Retinal fundus photograph.
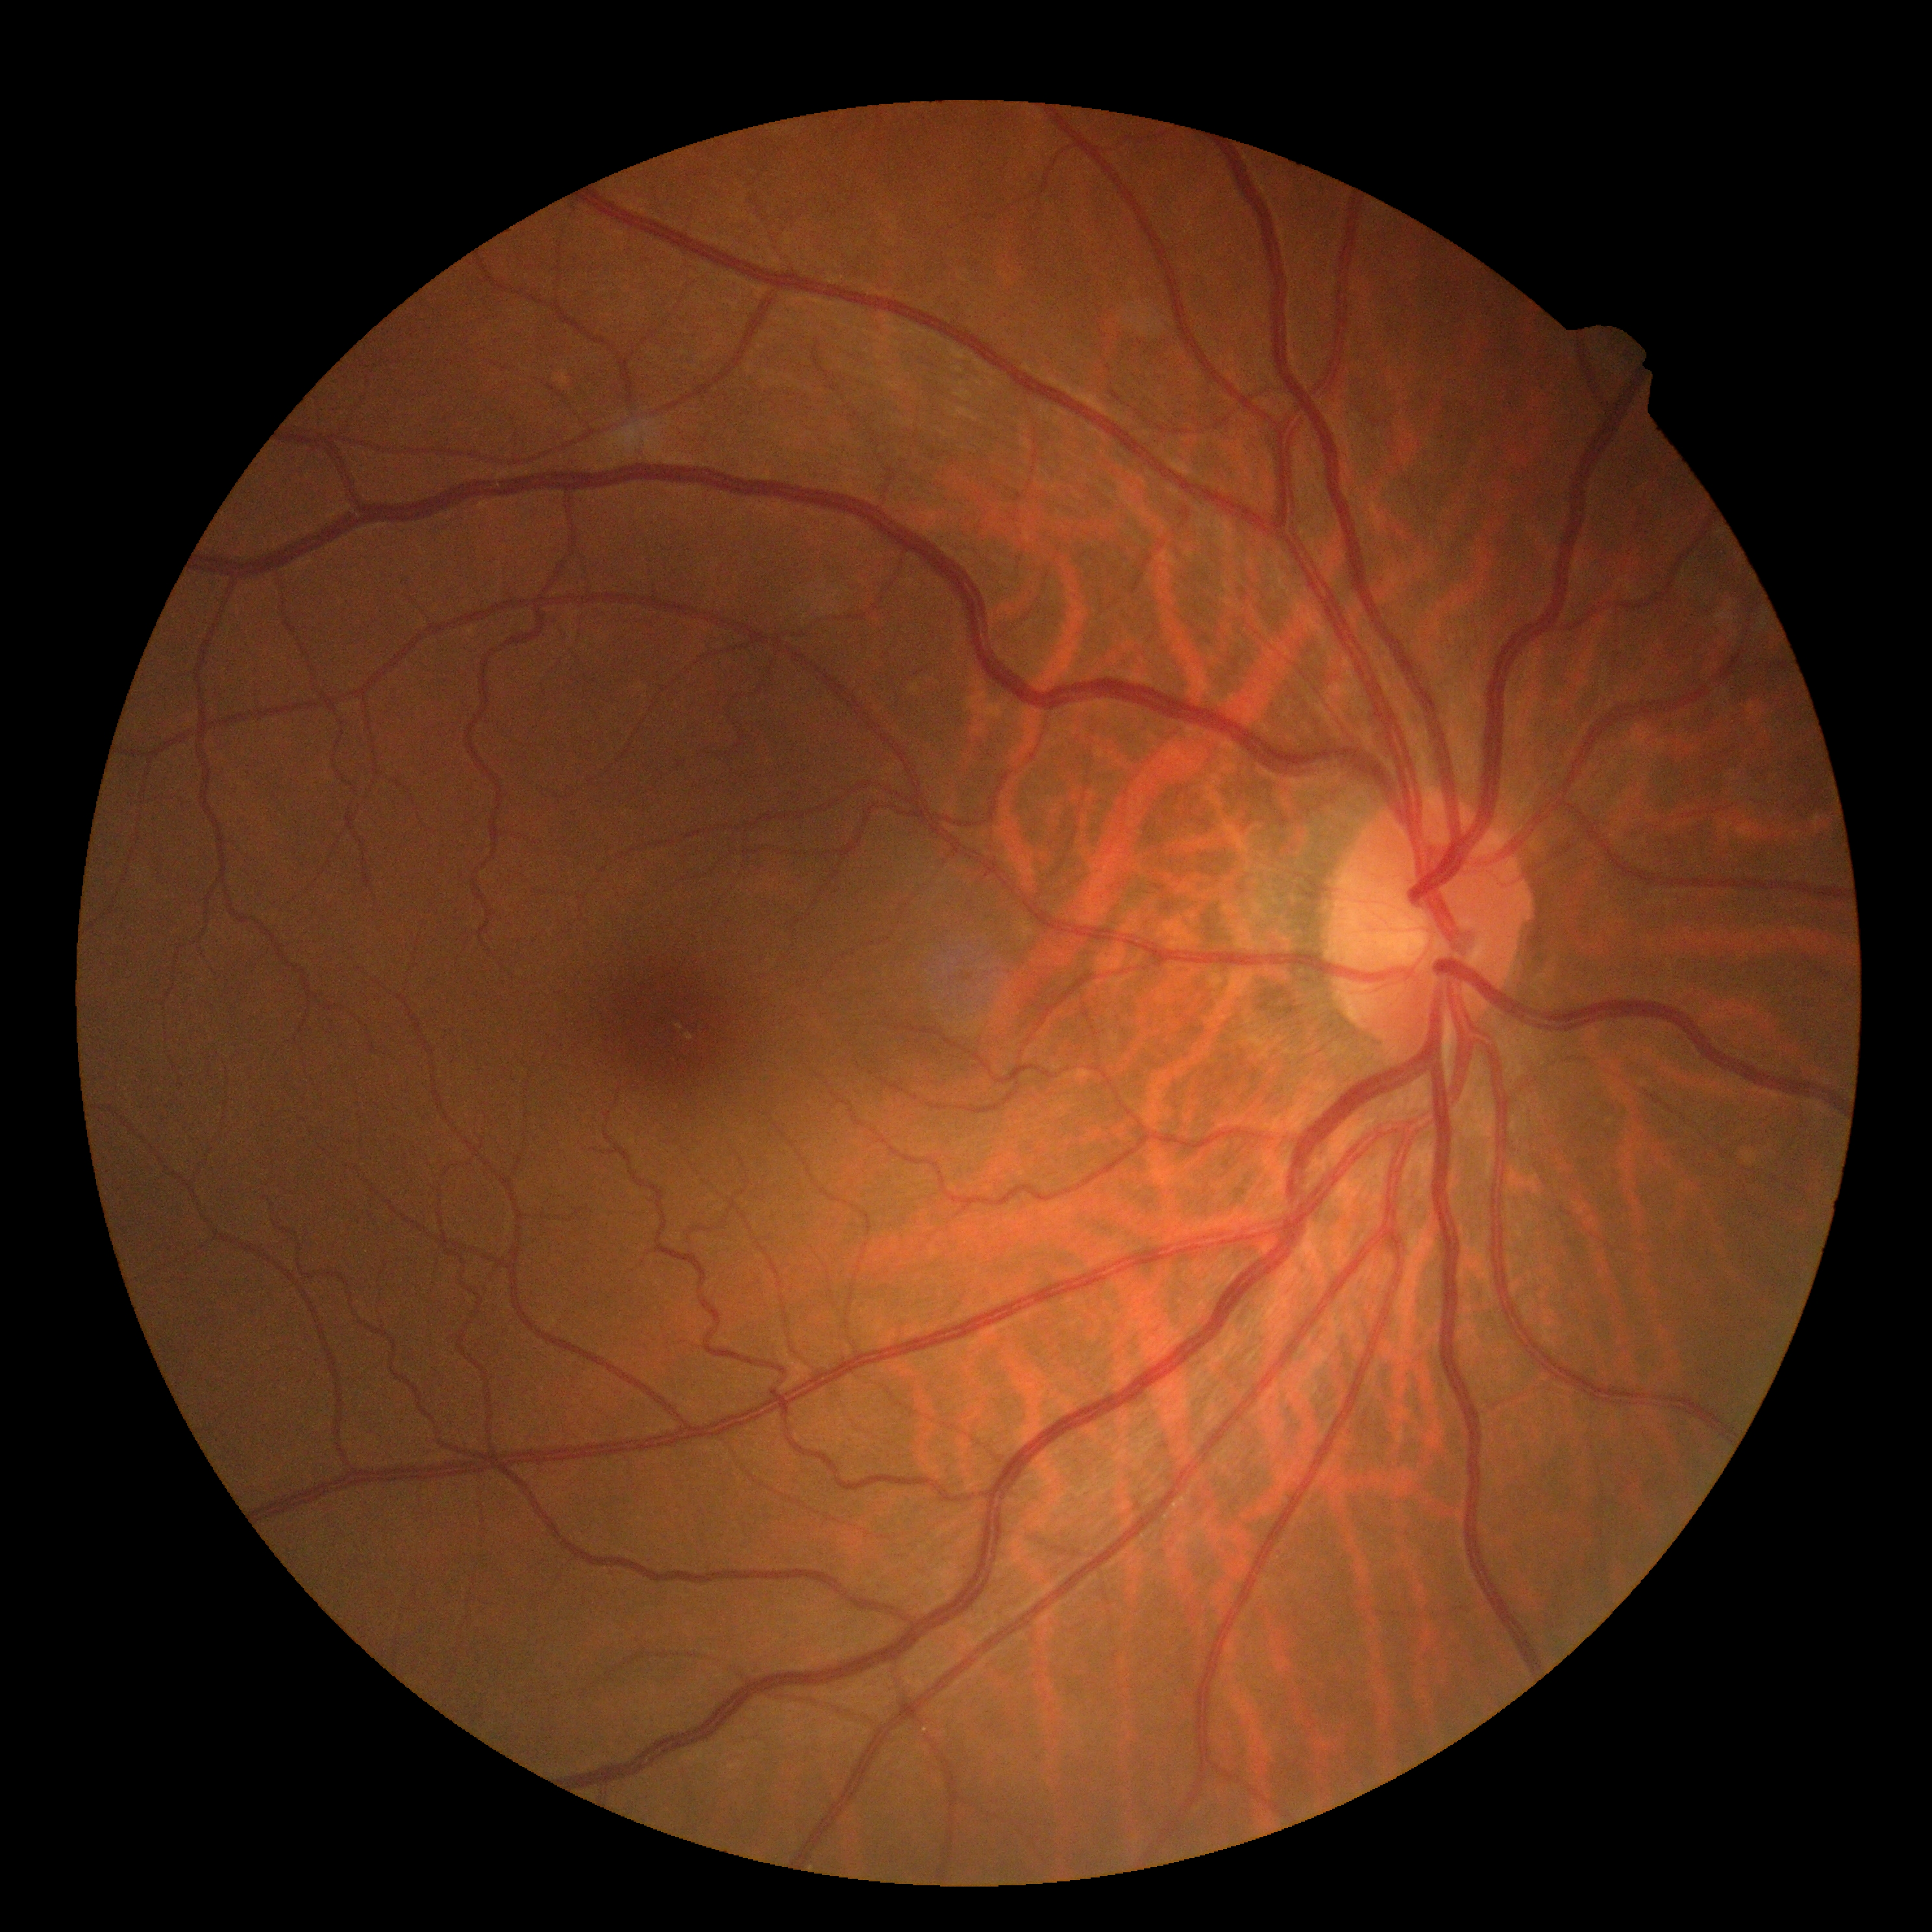
DR severity is grade 0 (no apparent retinopathy).